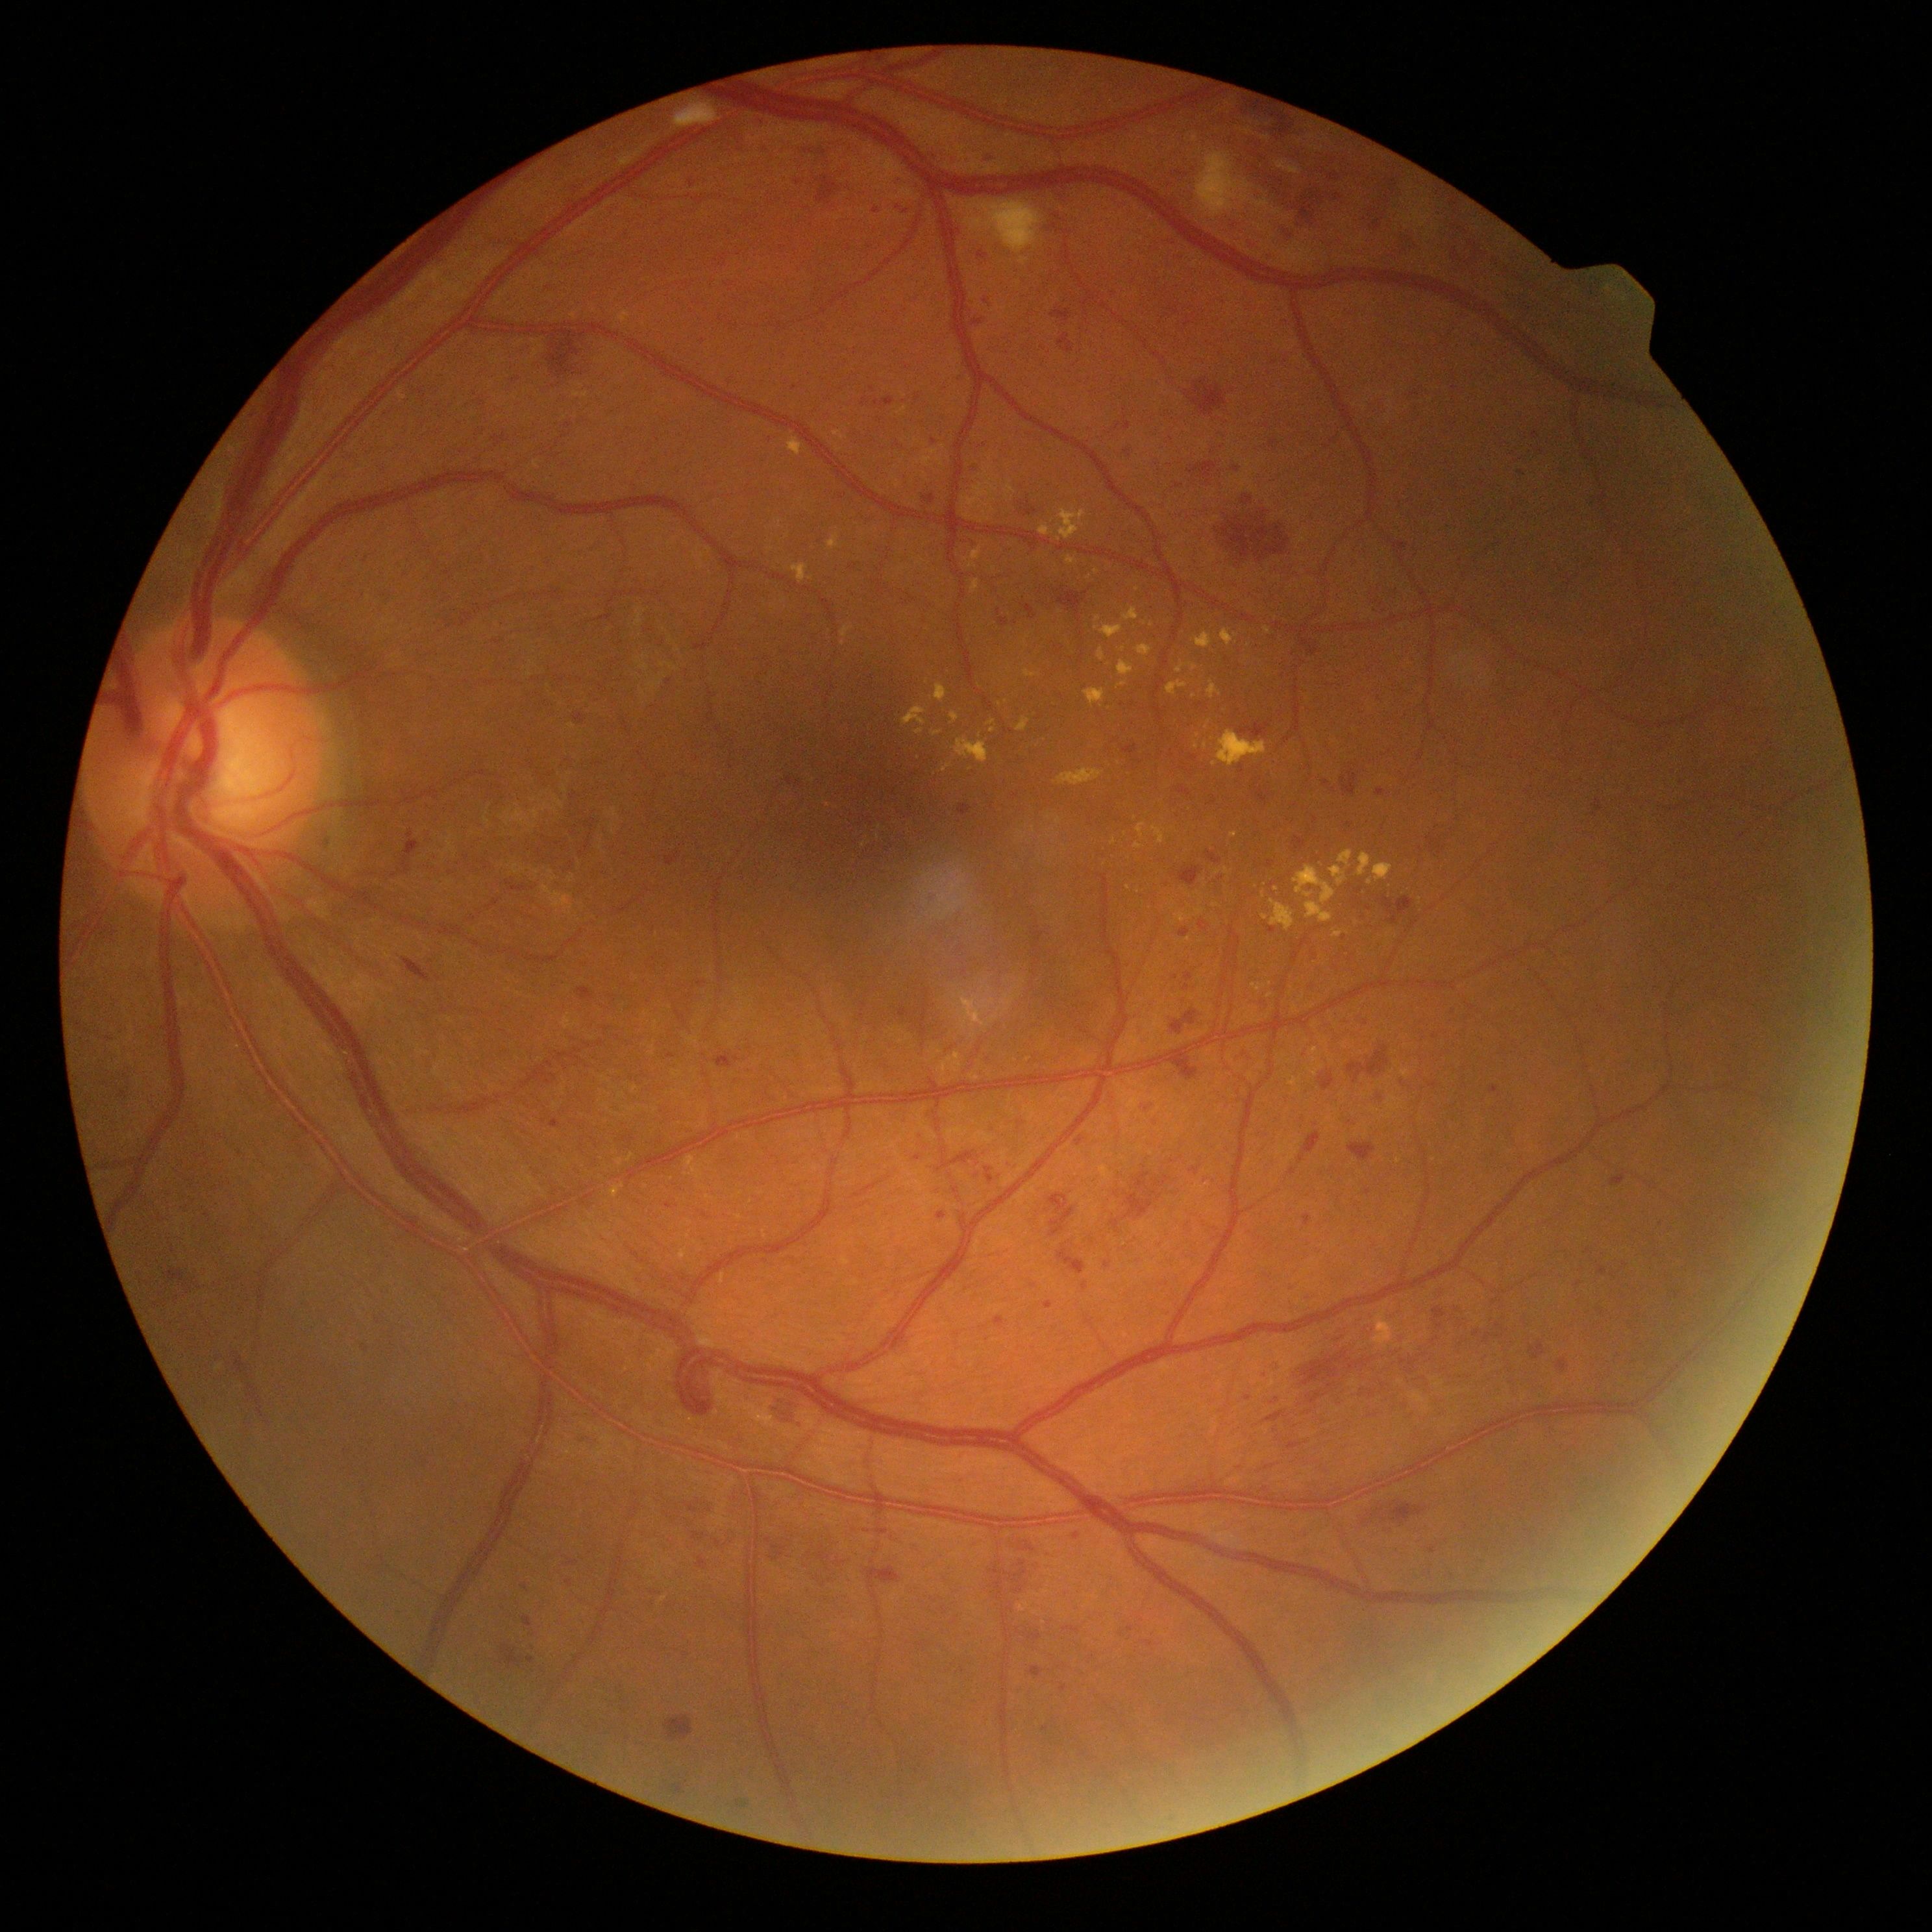
DR severity is severe non-proliferative diabetic retinopathy (grade 3).